45° field of view: 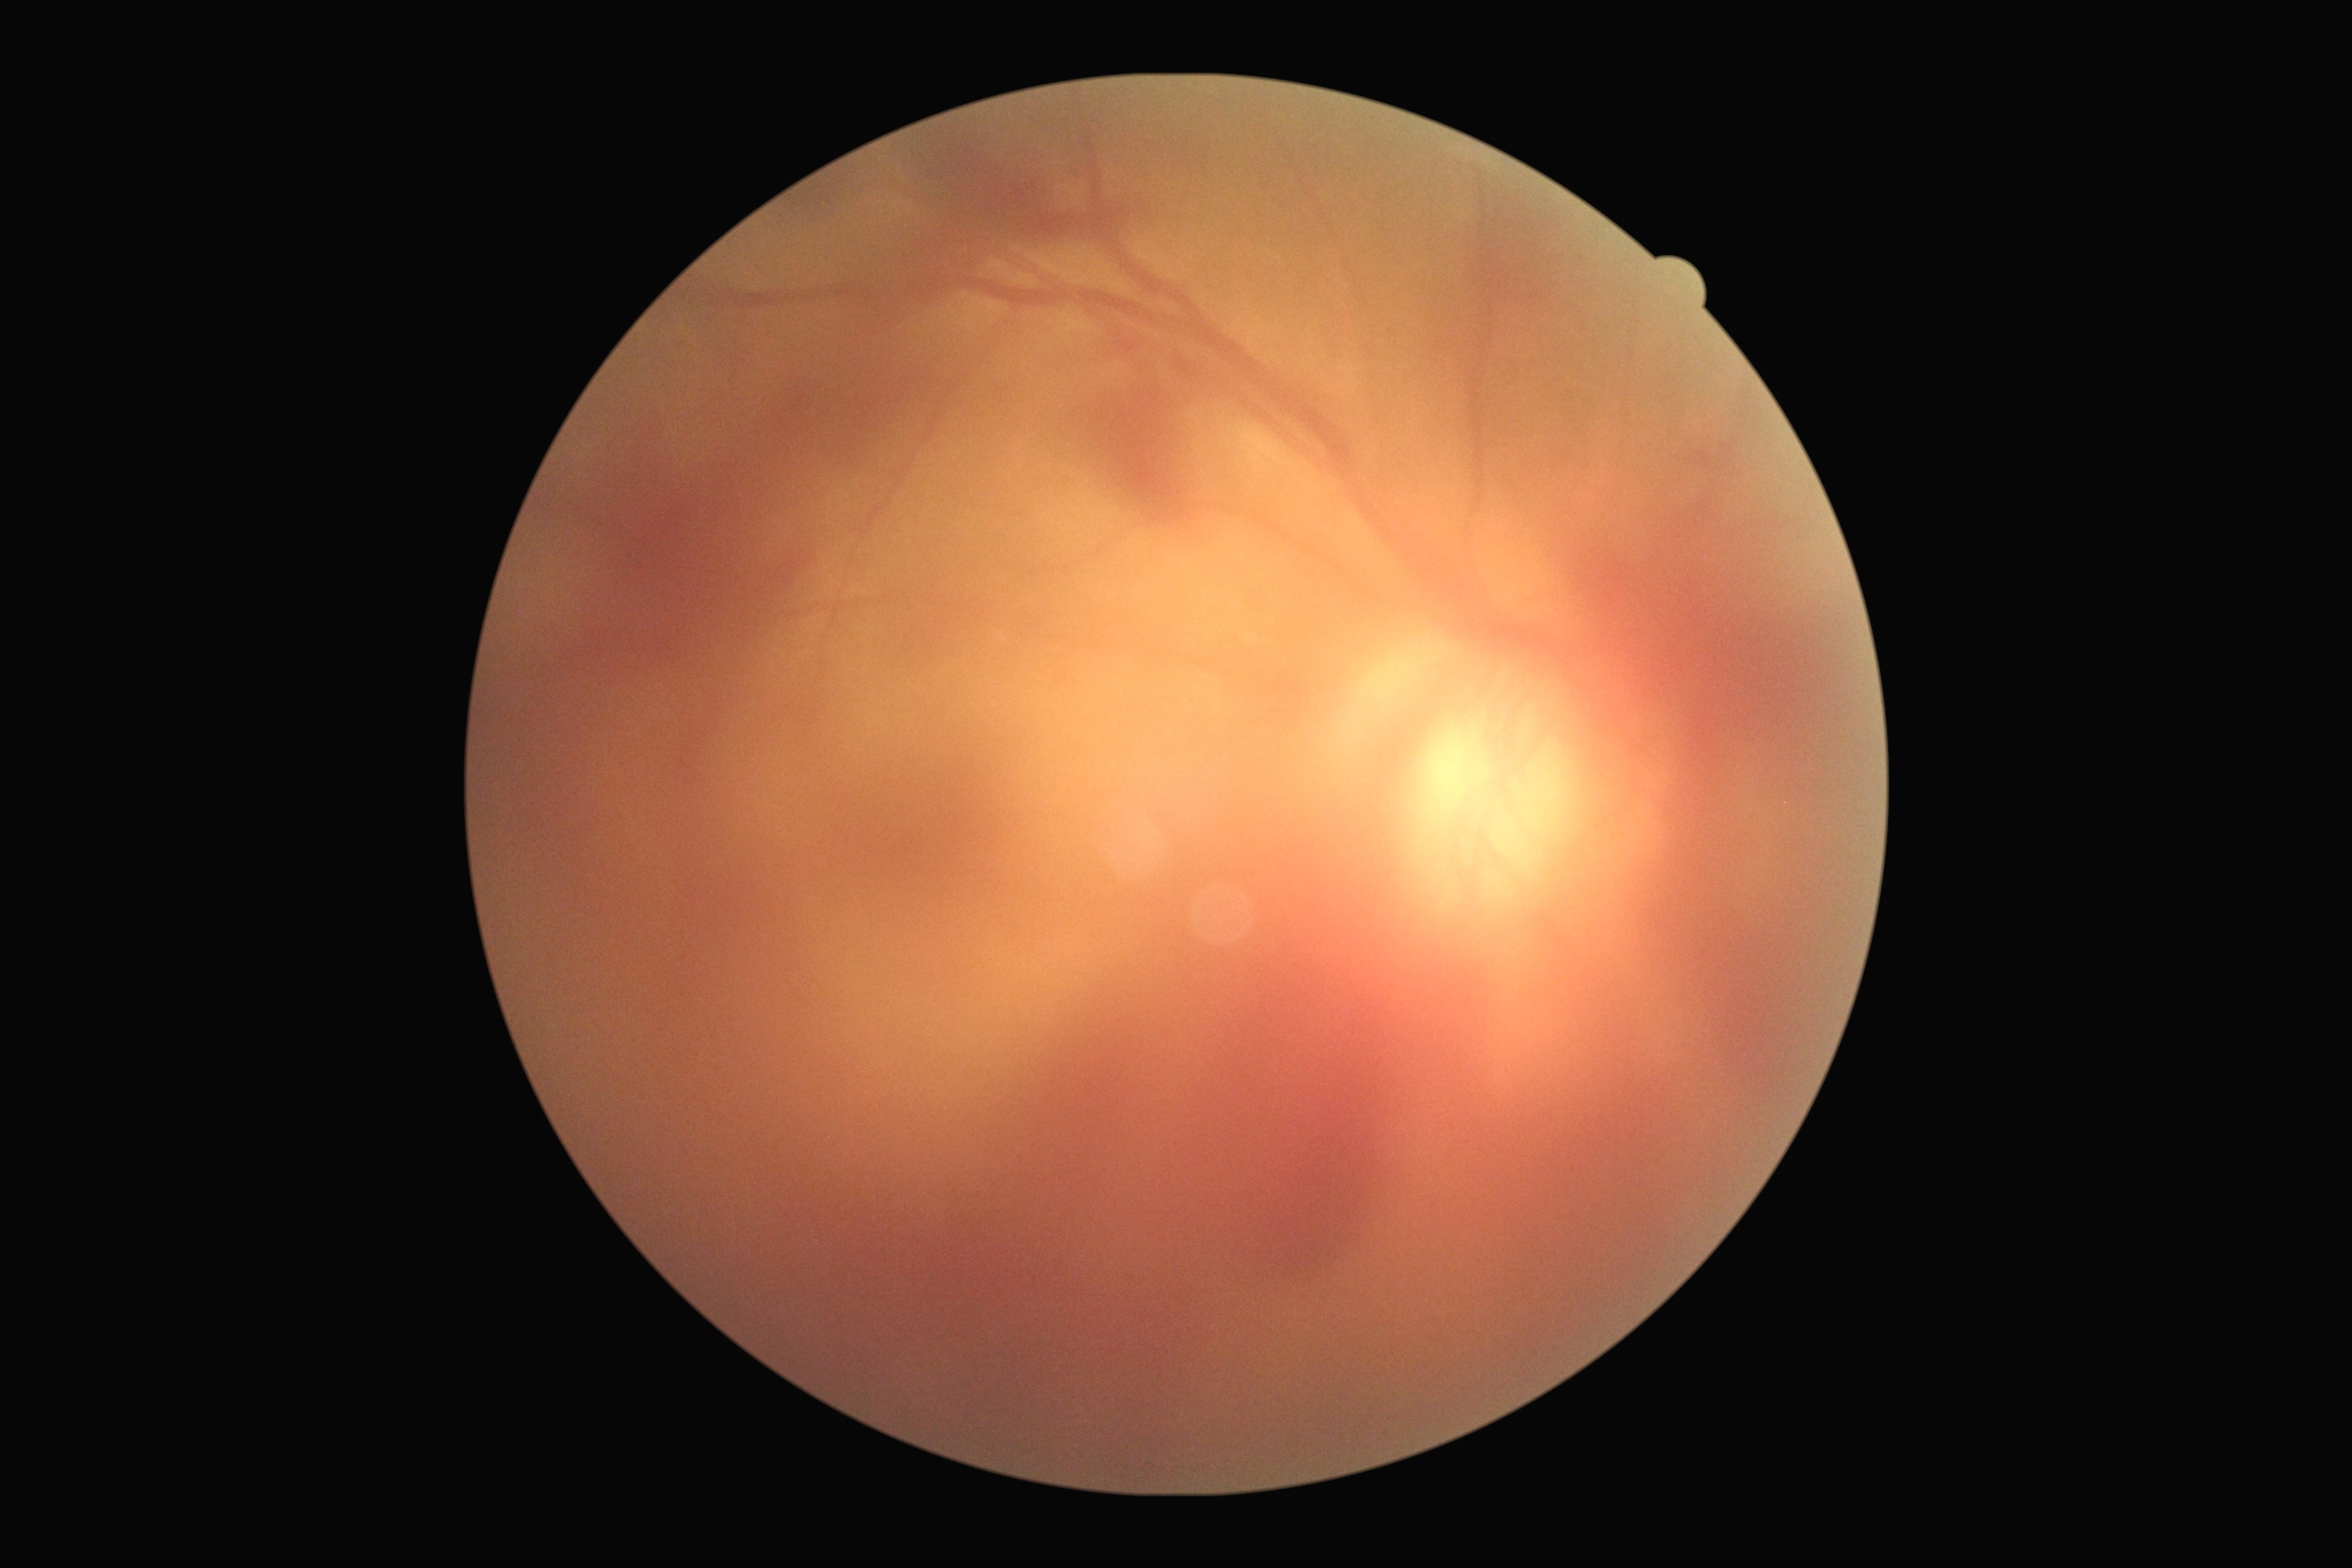 diabetic retinopathy (DR): 4/4 — neovascularization and/or vitreous/pre-retinal hemorrhage.